Wide-field retinal mosaic image
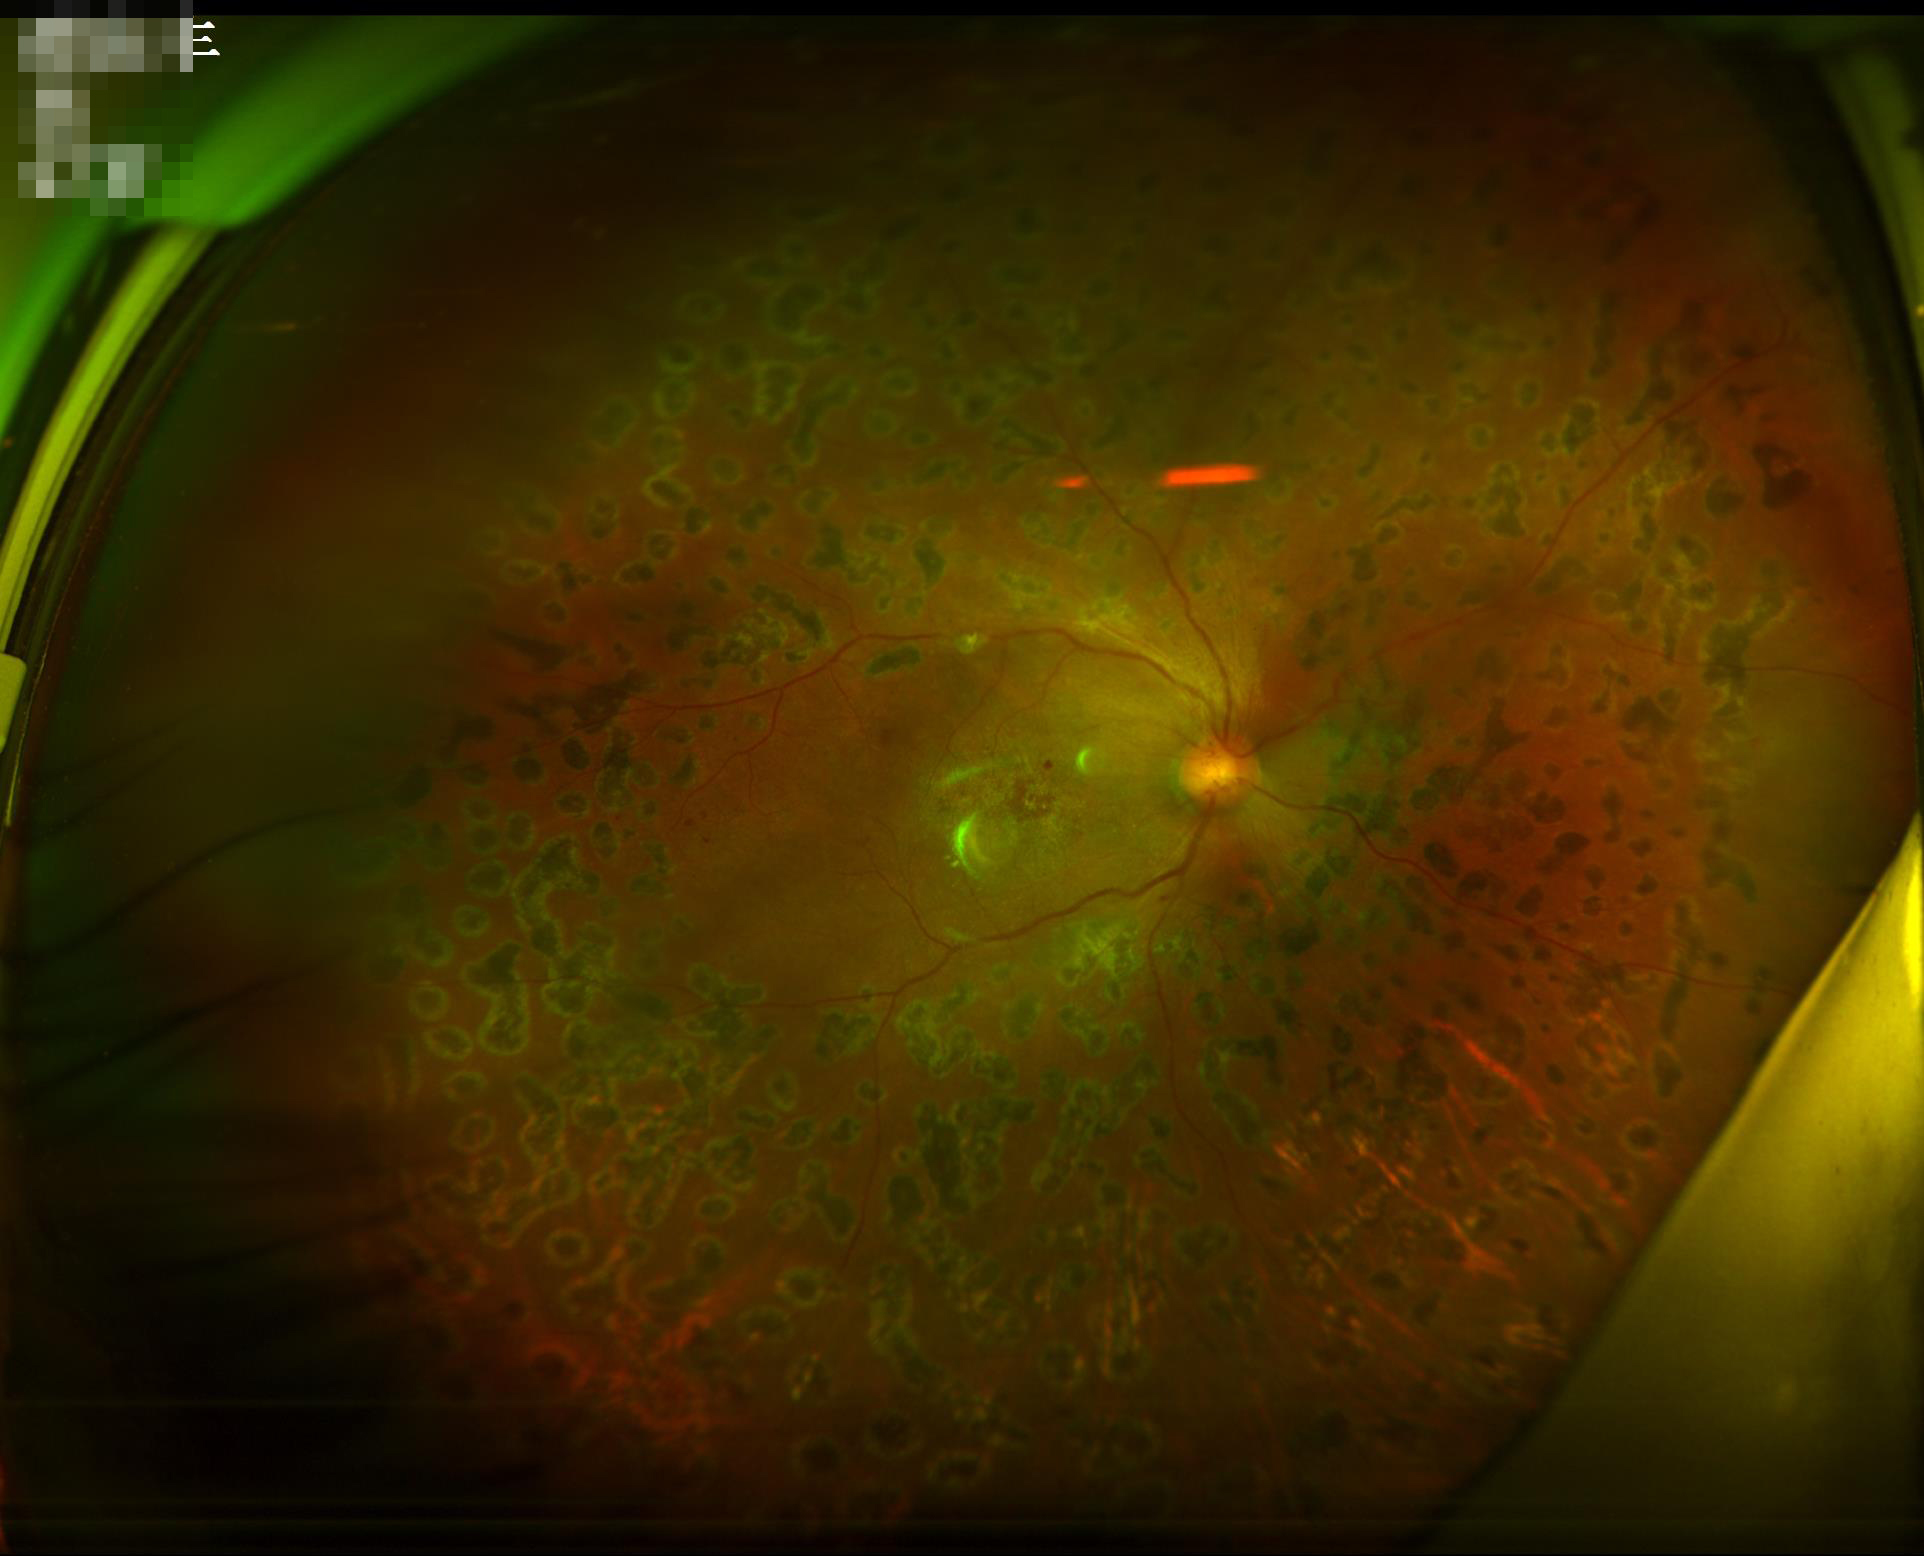 Image quality: illumination/color: poor; overall: low; focus: sharp.